CFP — 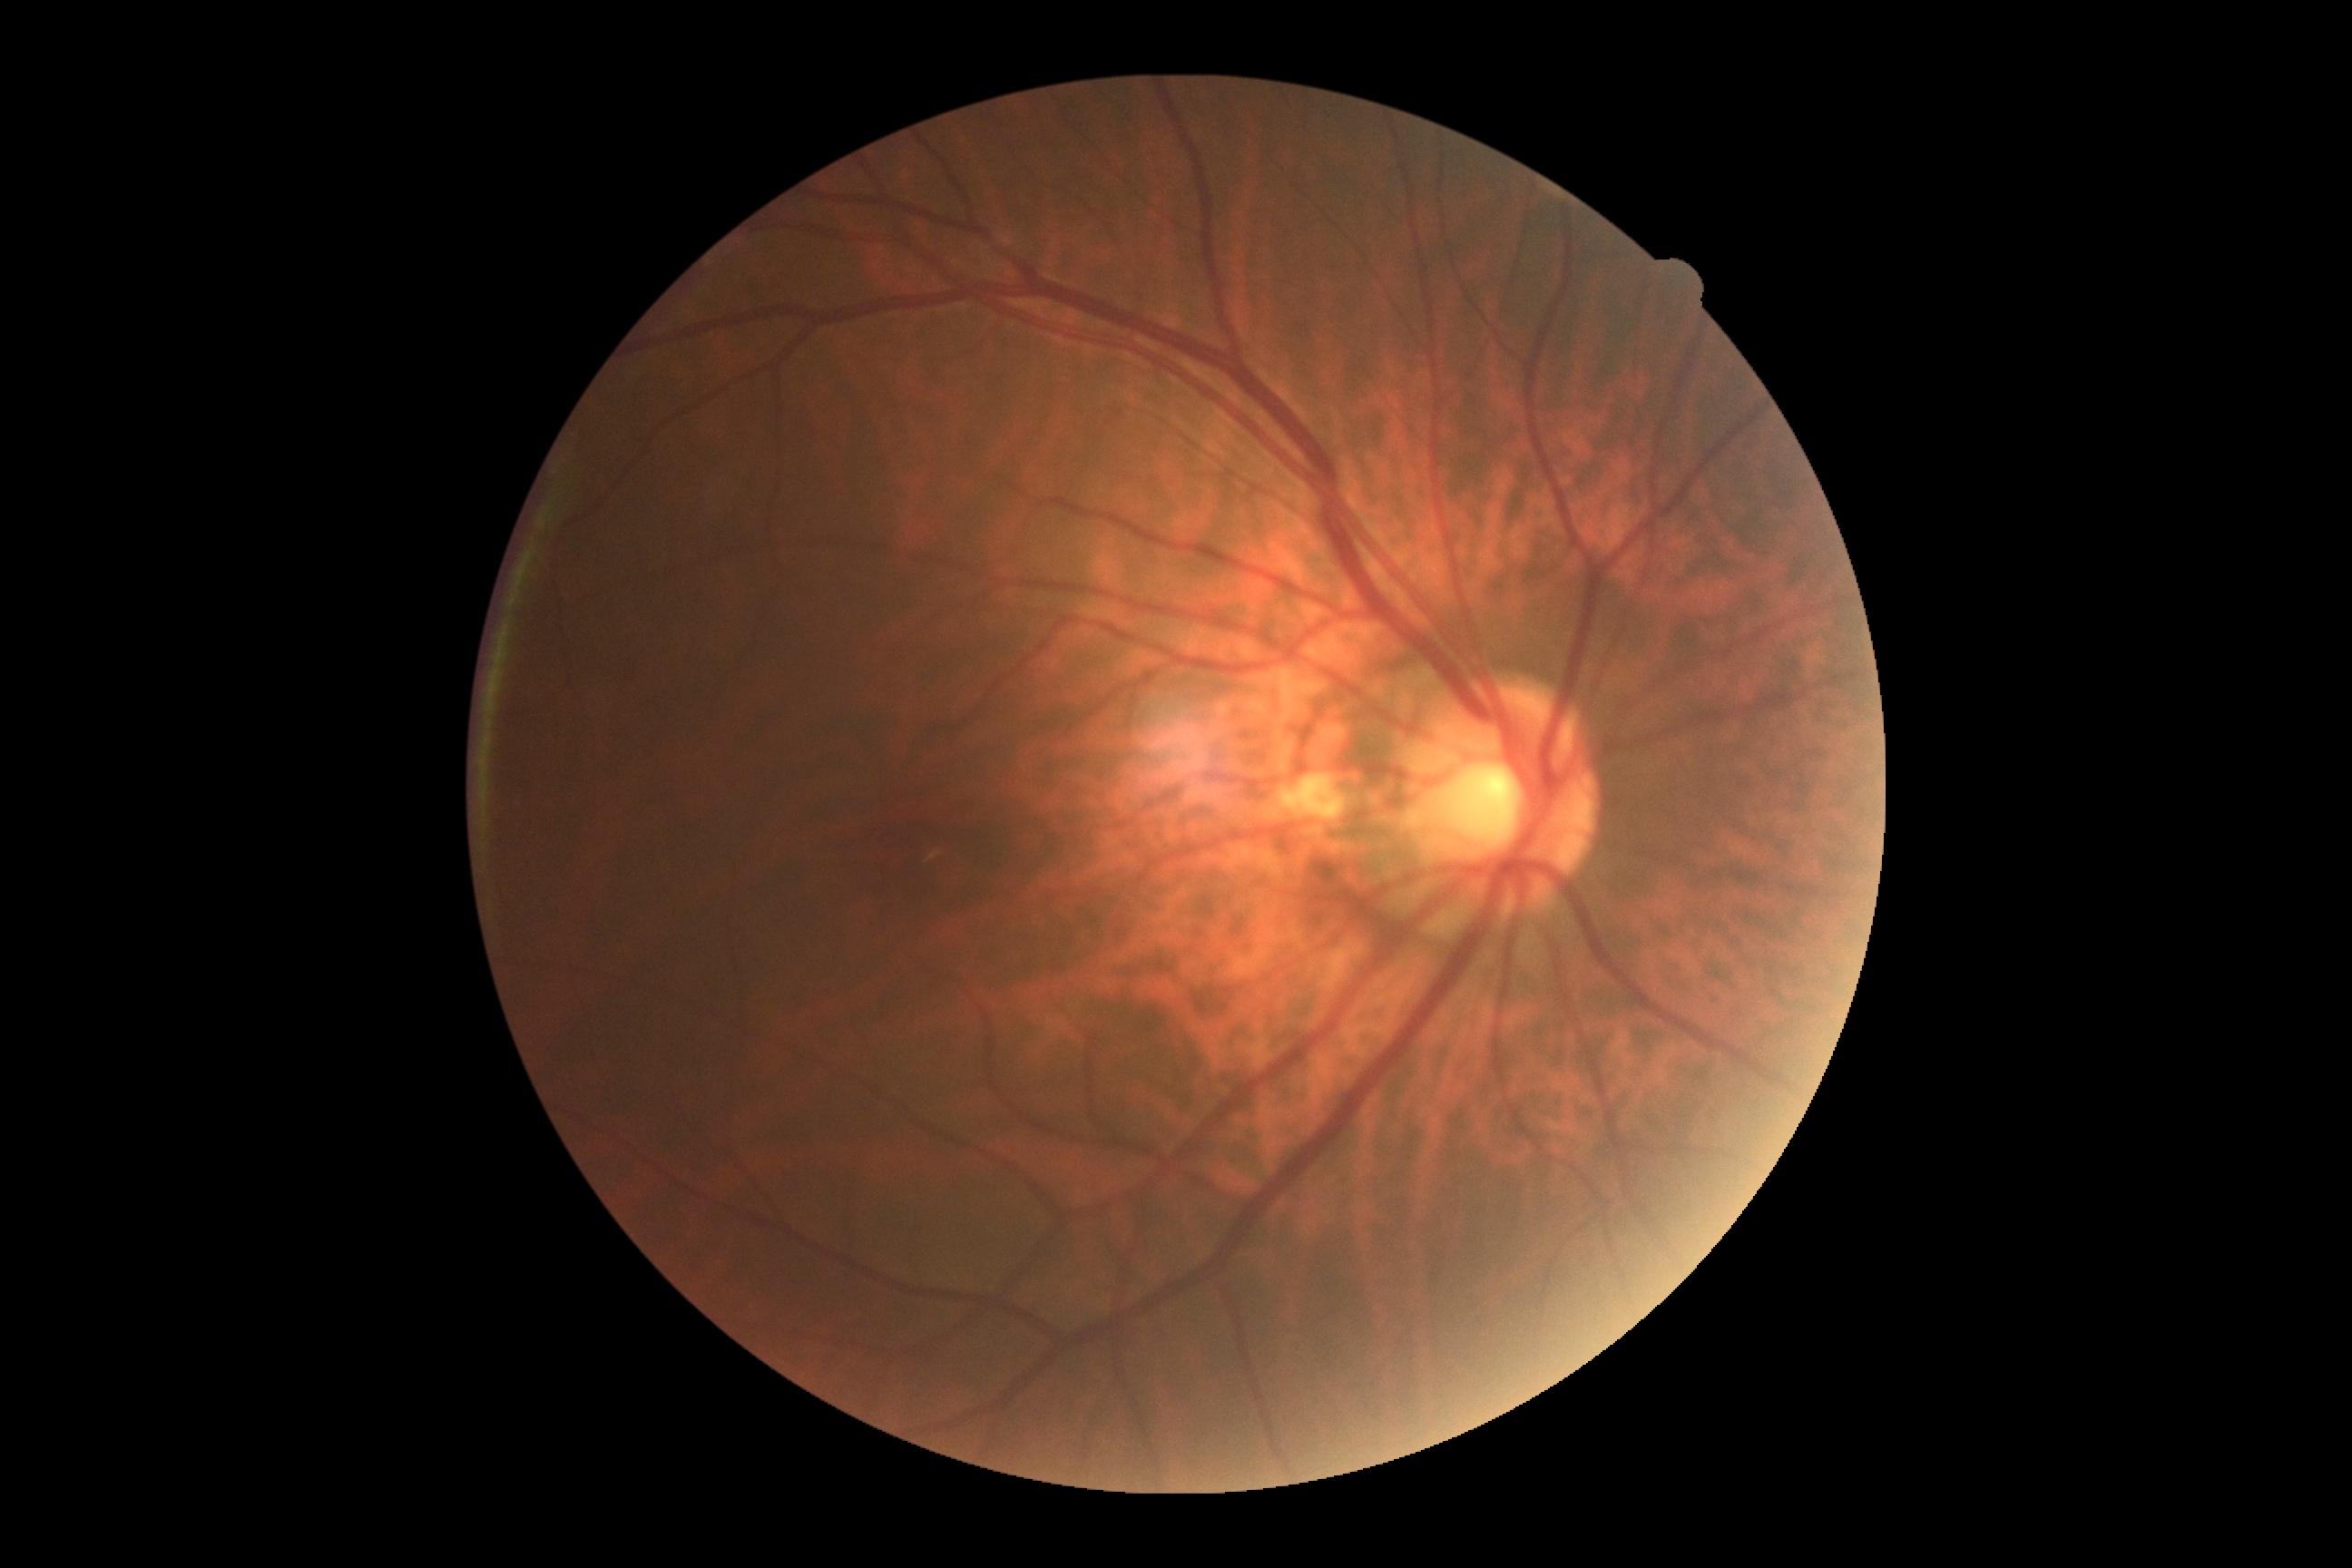 Annotations:
• diabetic retinopathy grade — 0/4